Color fundus photograph. 2048 x 1536 pixels
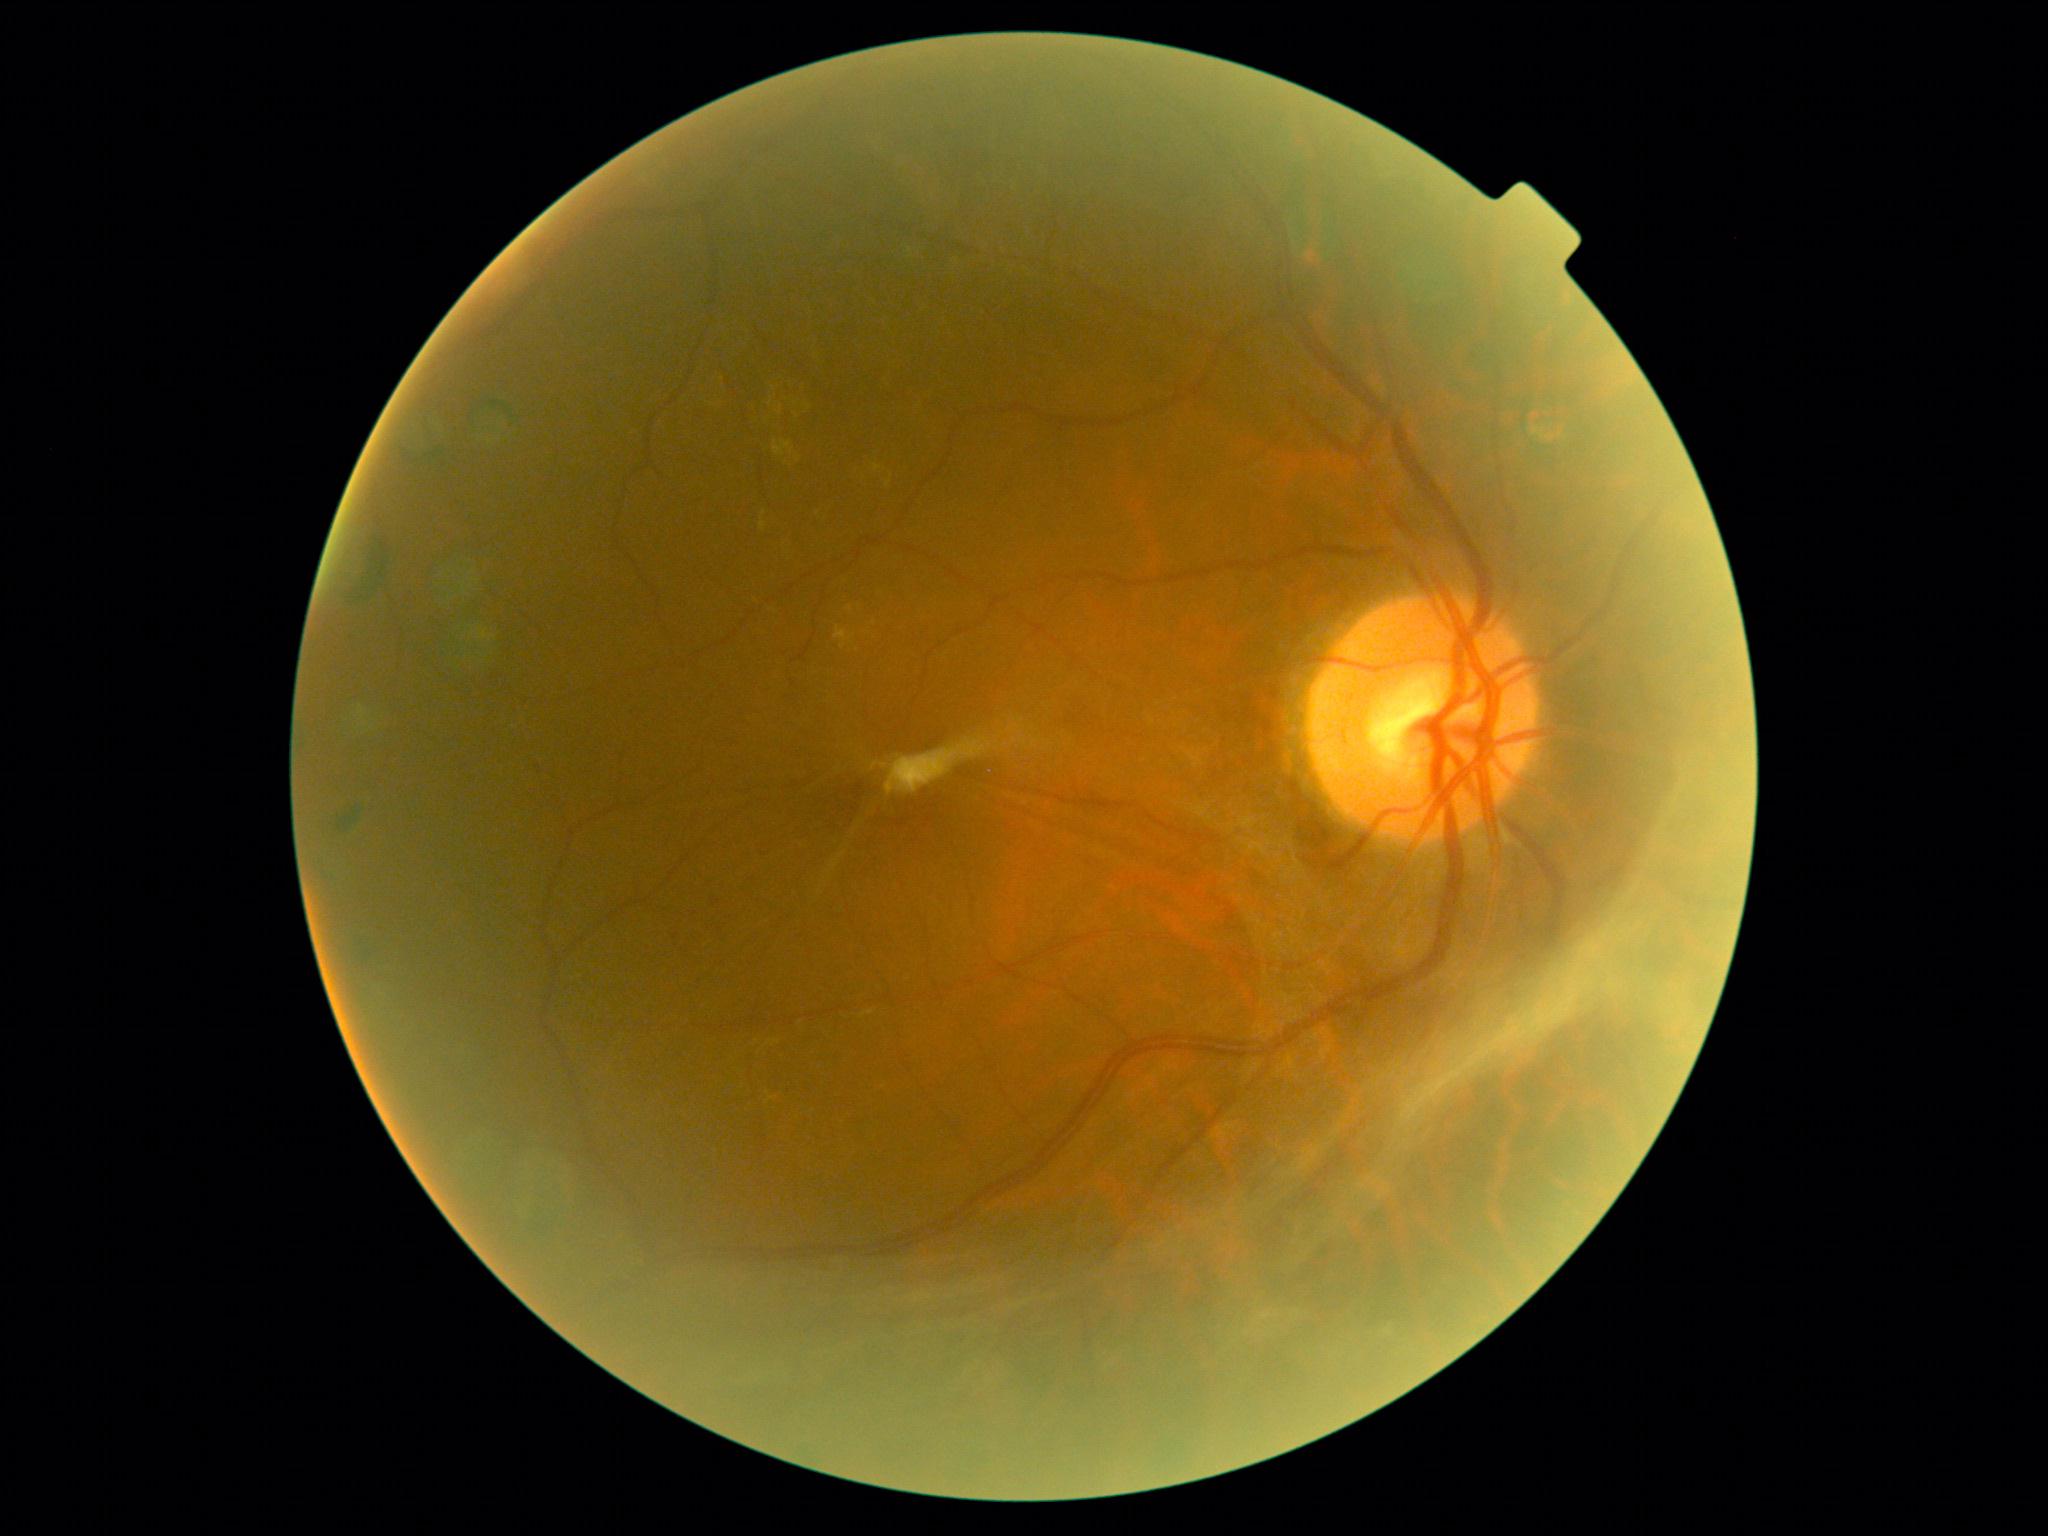
DR: grade 4. DR class: proliferative diabetic retinopathy.